Color fundus photograph: 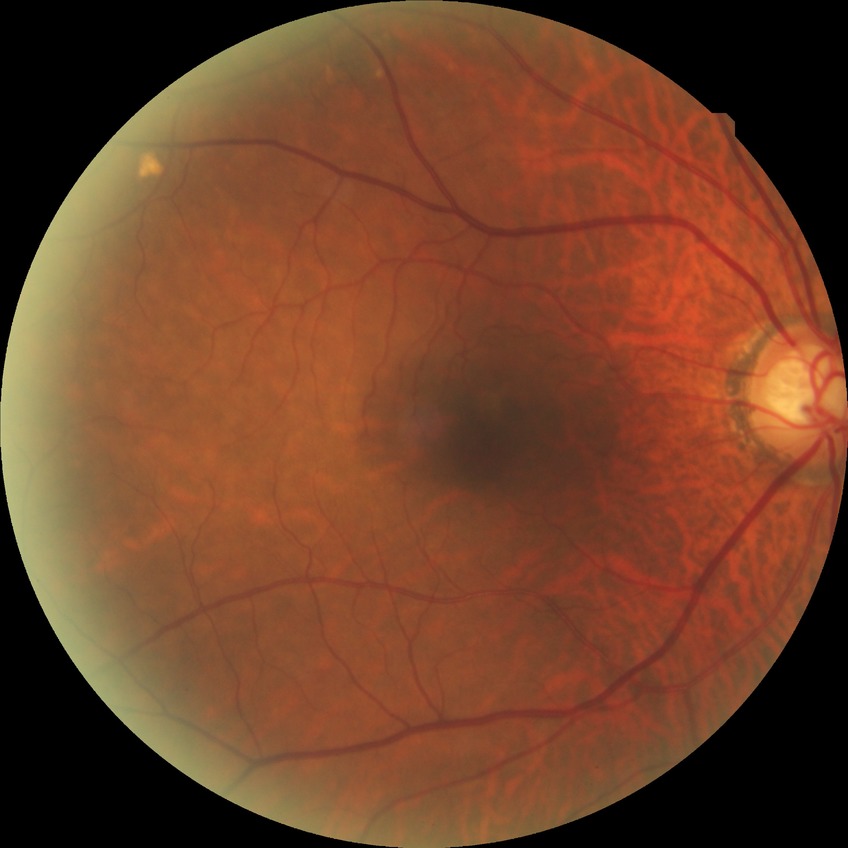 Diabetic retinopathy grade is no diabetic retinopathy.